FOV: 45 degrees; color fundus photograph: 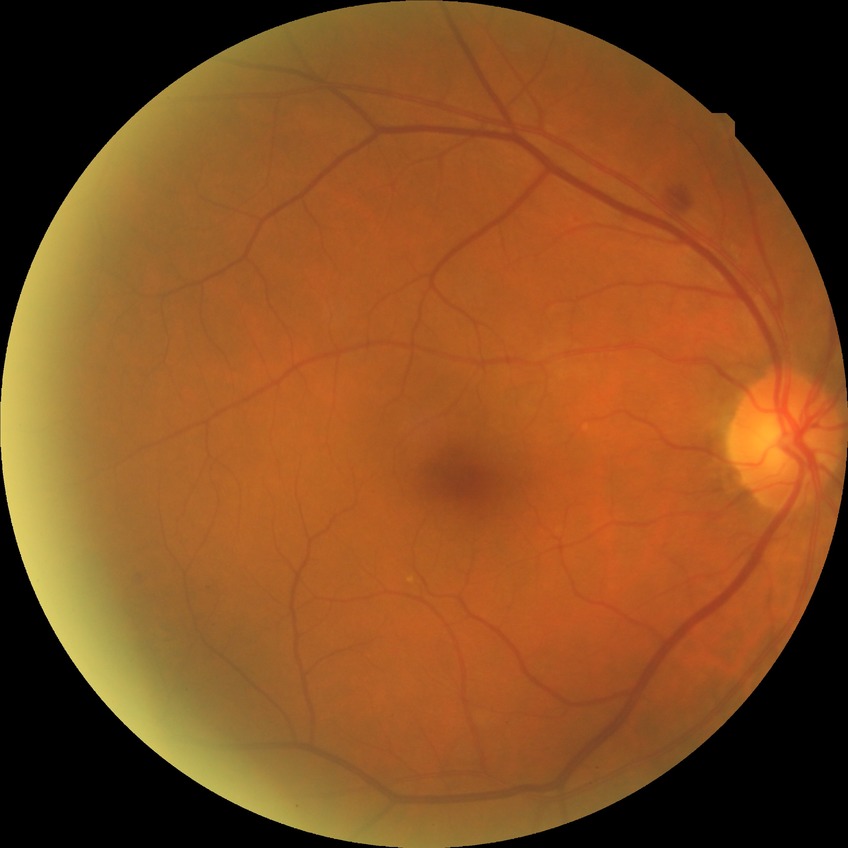 proliferative_class: non-proliferative diabetic retinopathy
davis_grade: simple diabetic retinopathy (SDR)